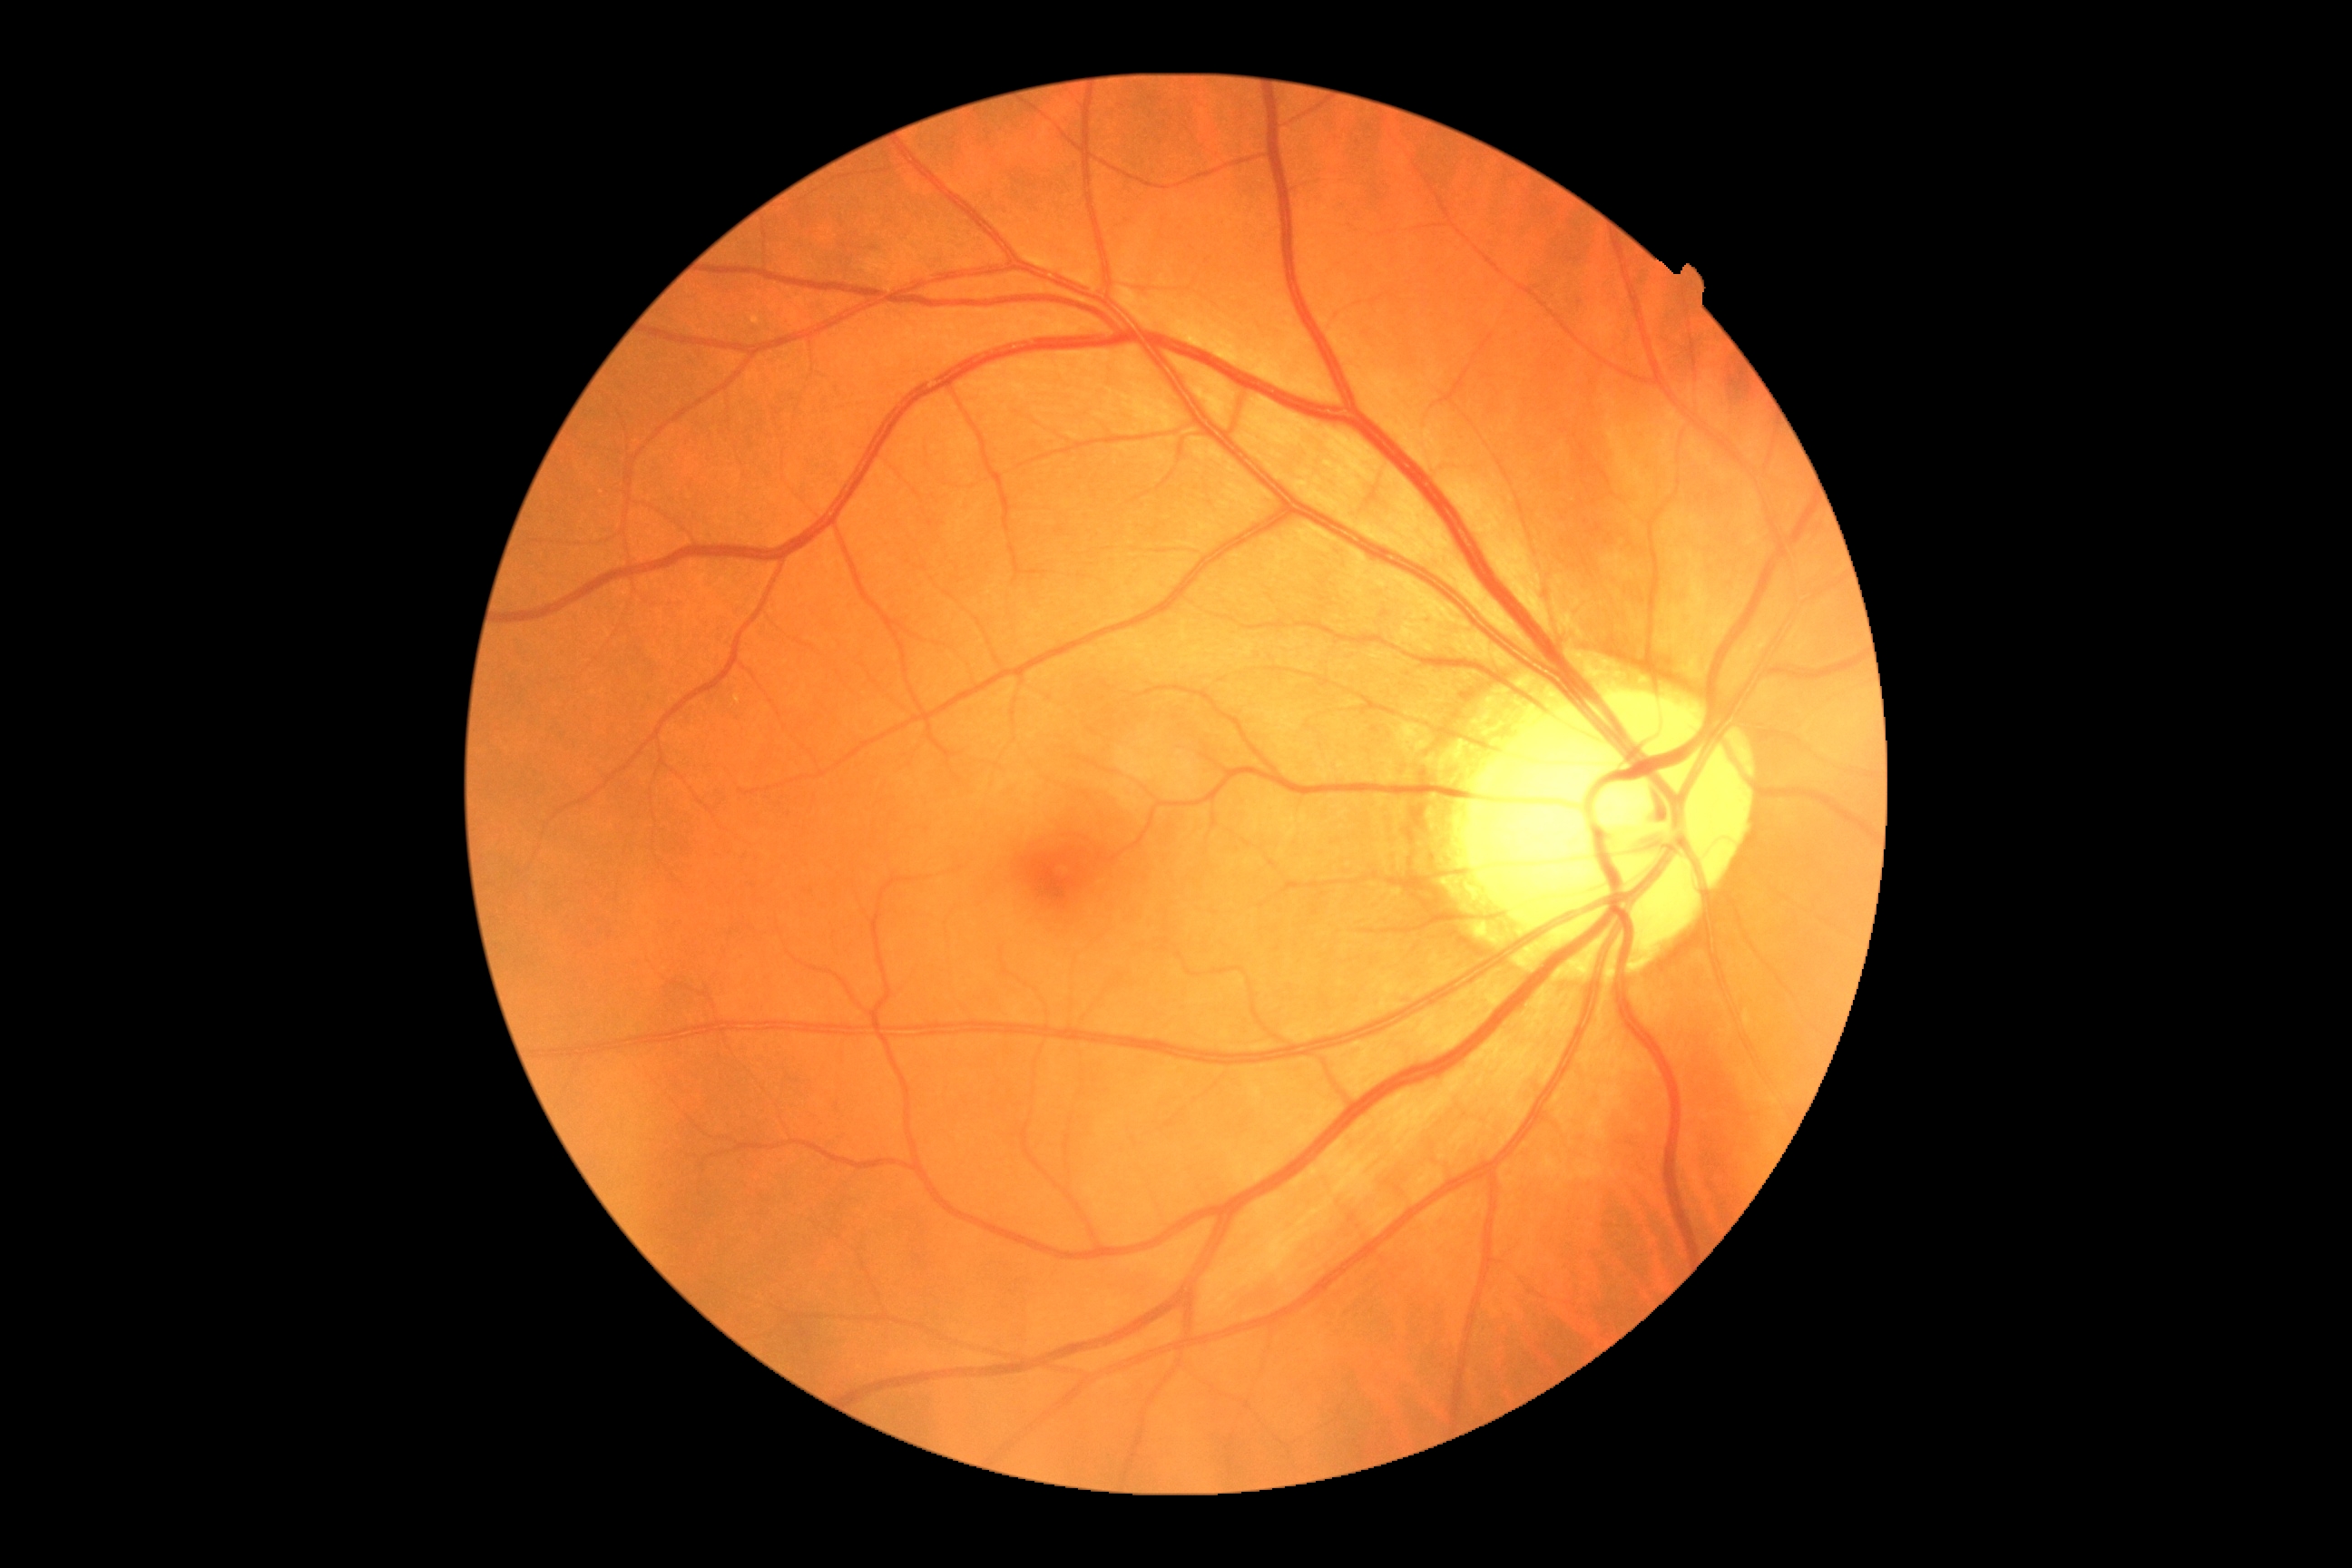 DR: 0.